DR severity per modified Davis staging — 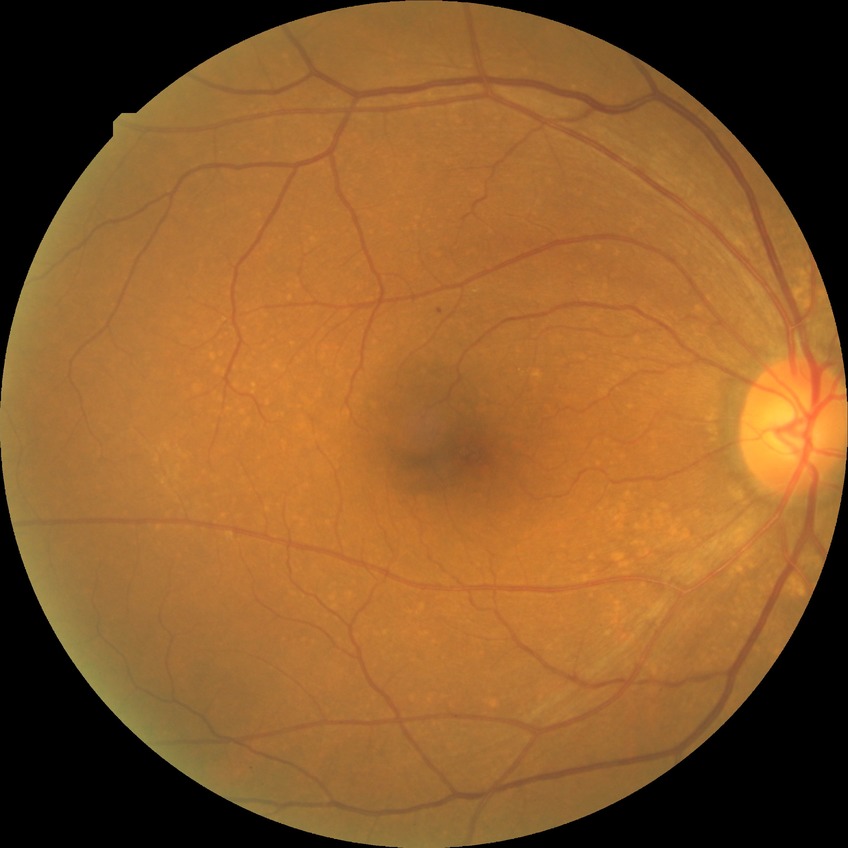
Diabetic retinopathy (DR): SDR (simple diabetic retinopathy).